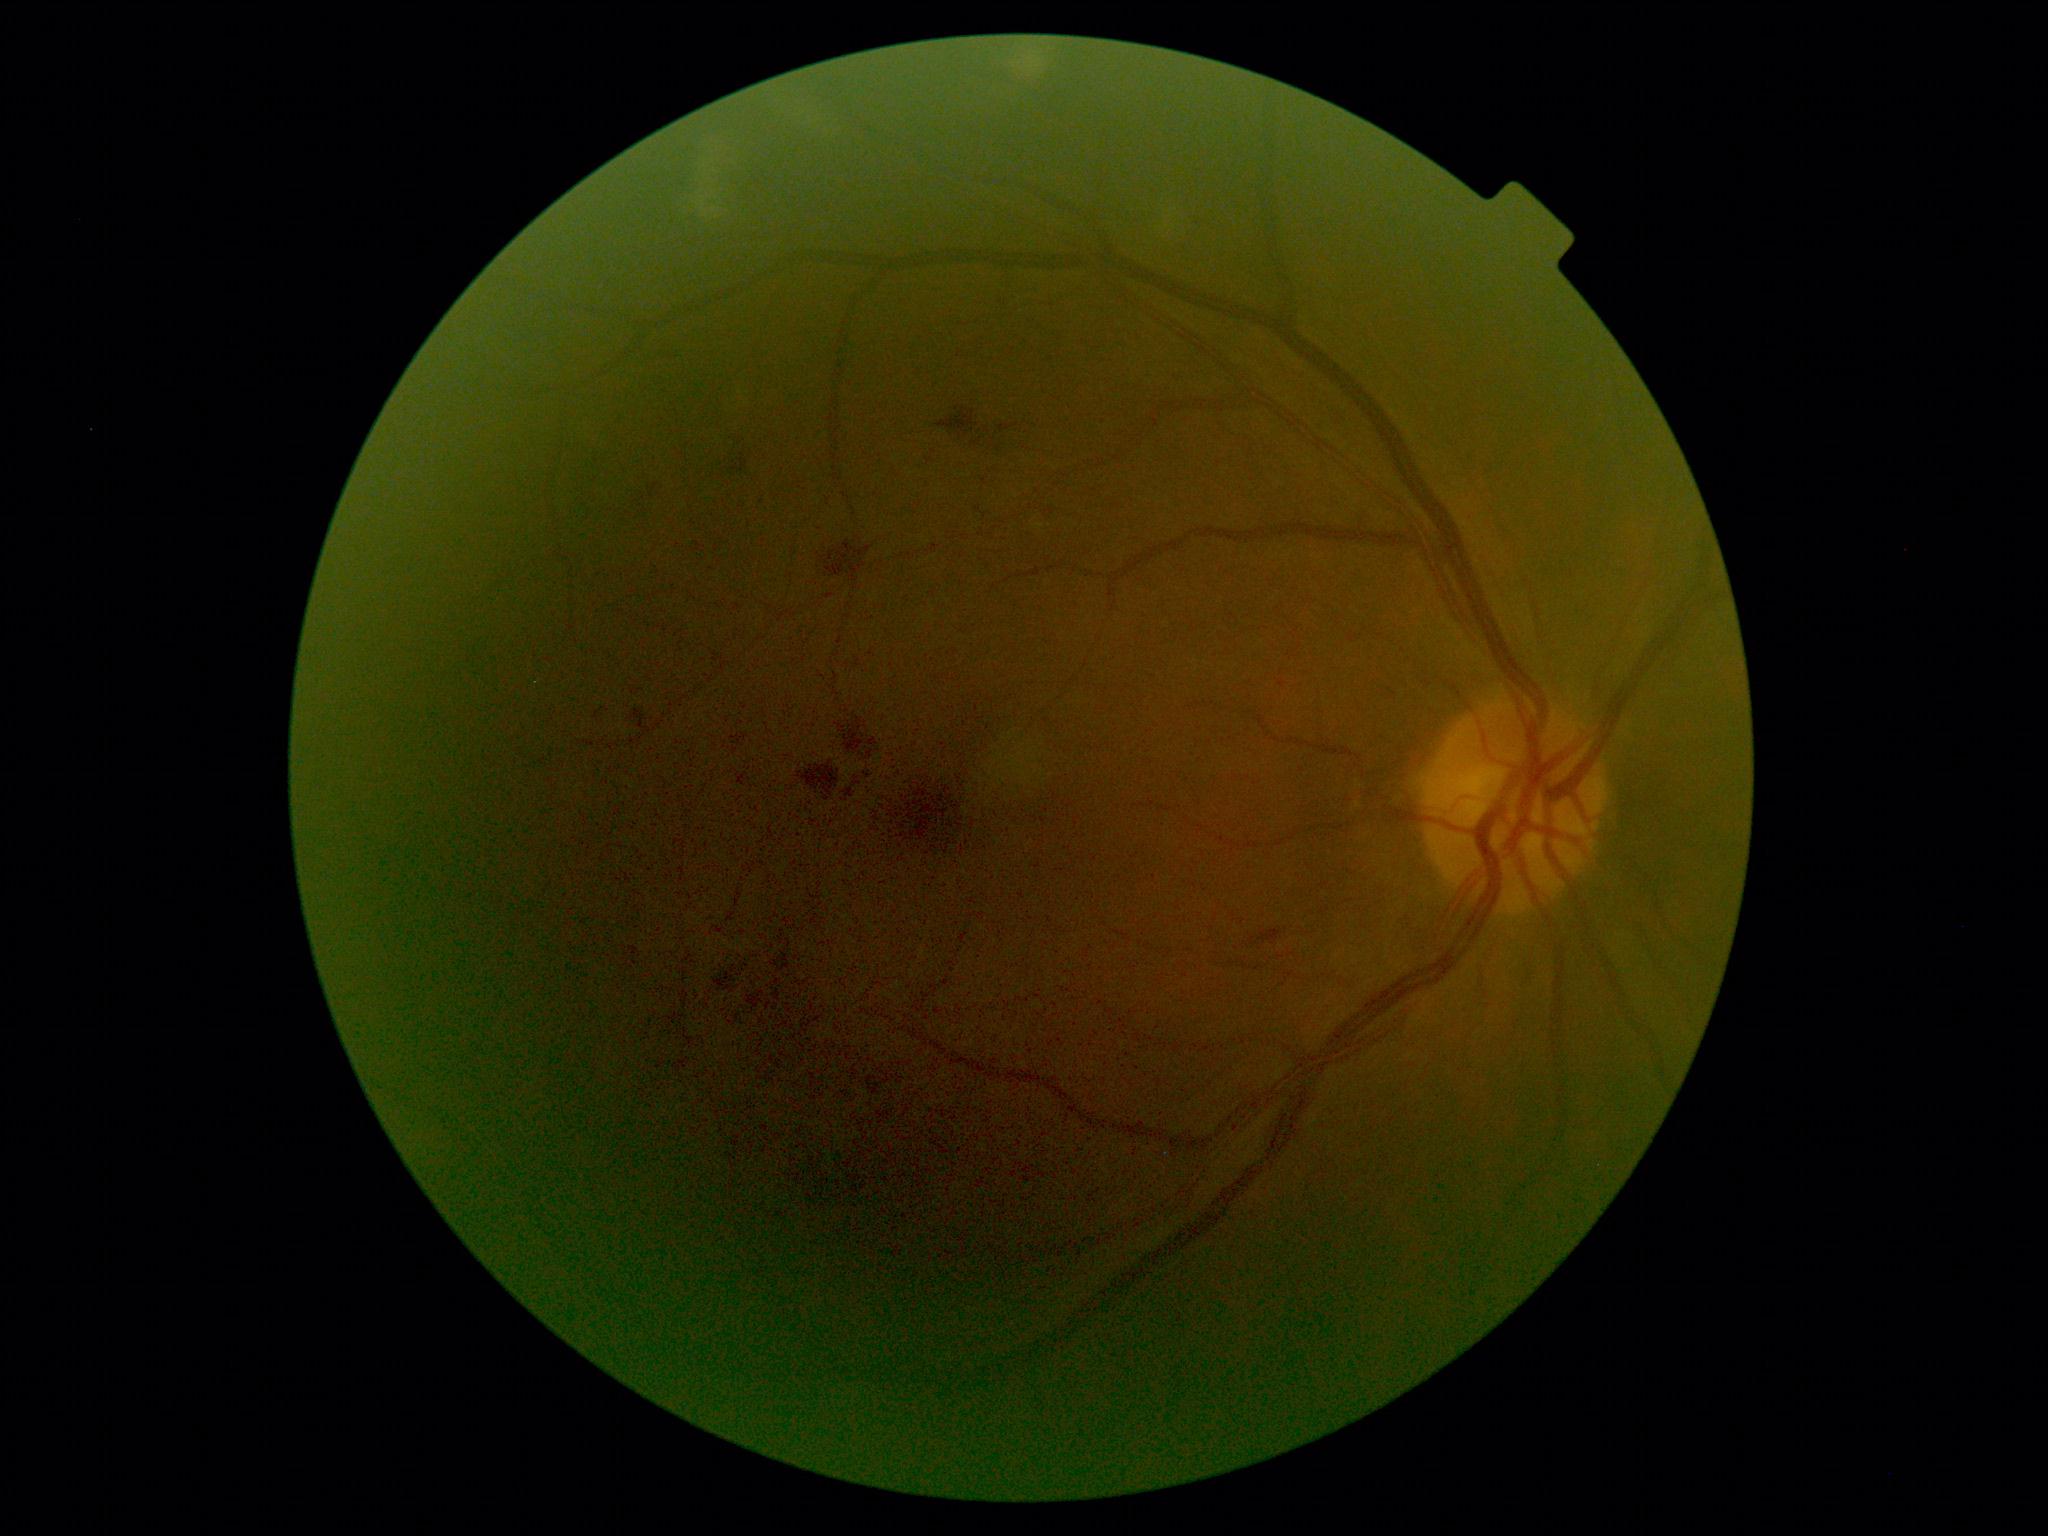

DR severity is grade 2 — more than just microaneurysms but less than severe NPDR.